45° field of view. Retinal fundus photograph. Image size 2048x1536:
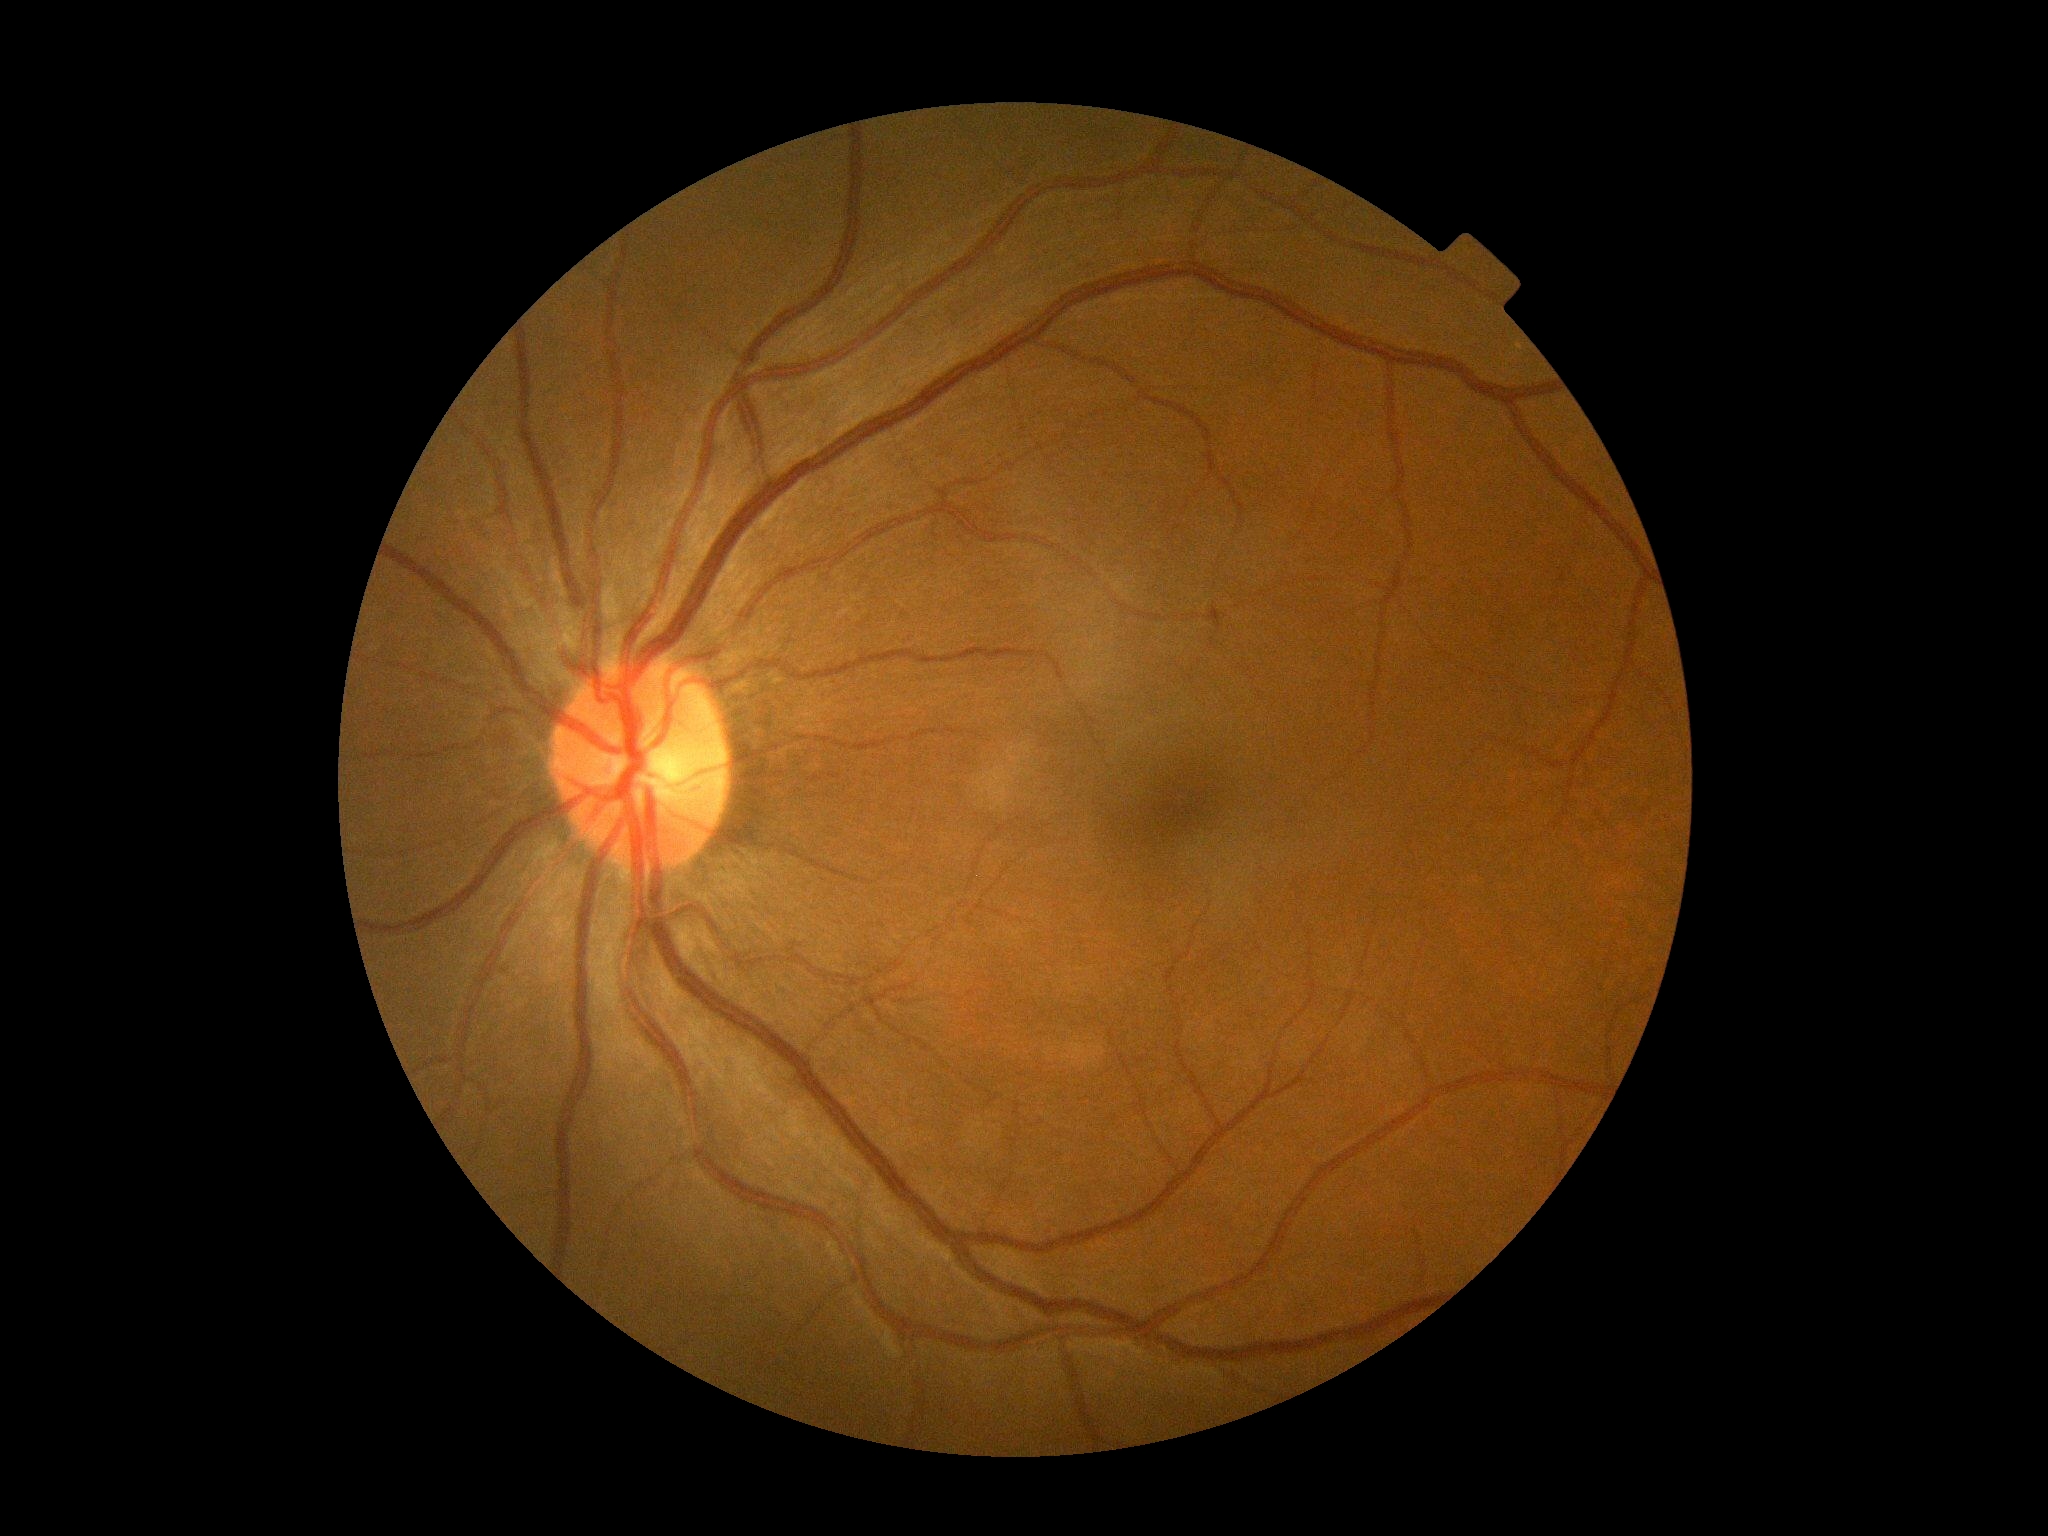
No DR findings. Diabetic retinopathy (DR): no apparent retinopathy (grade 0).